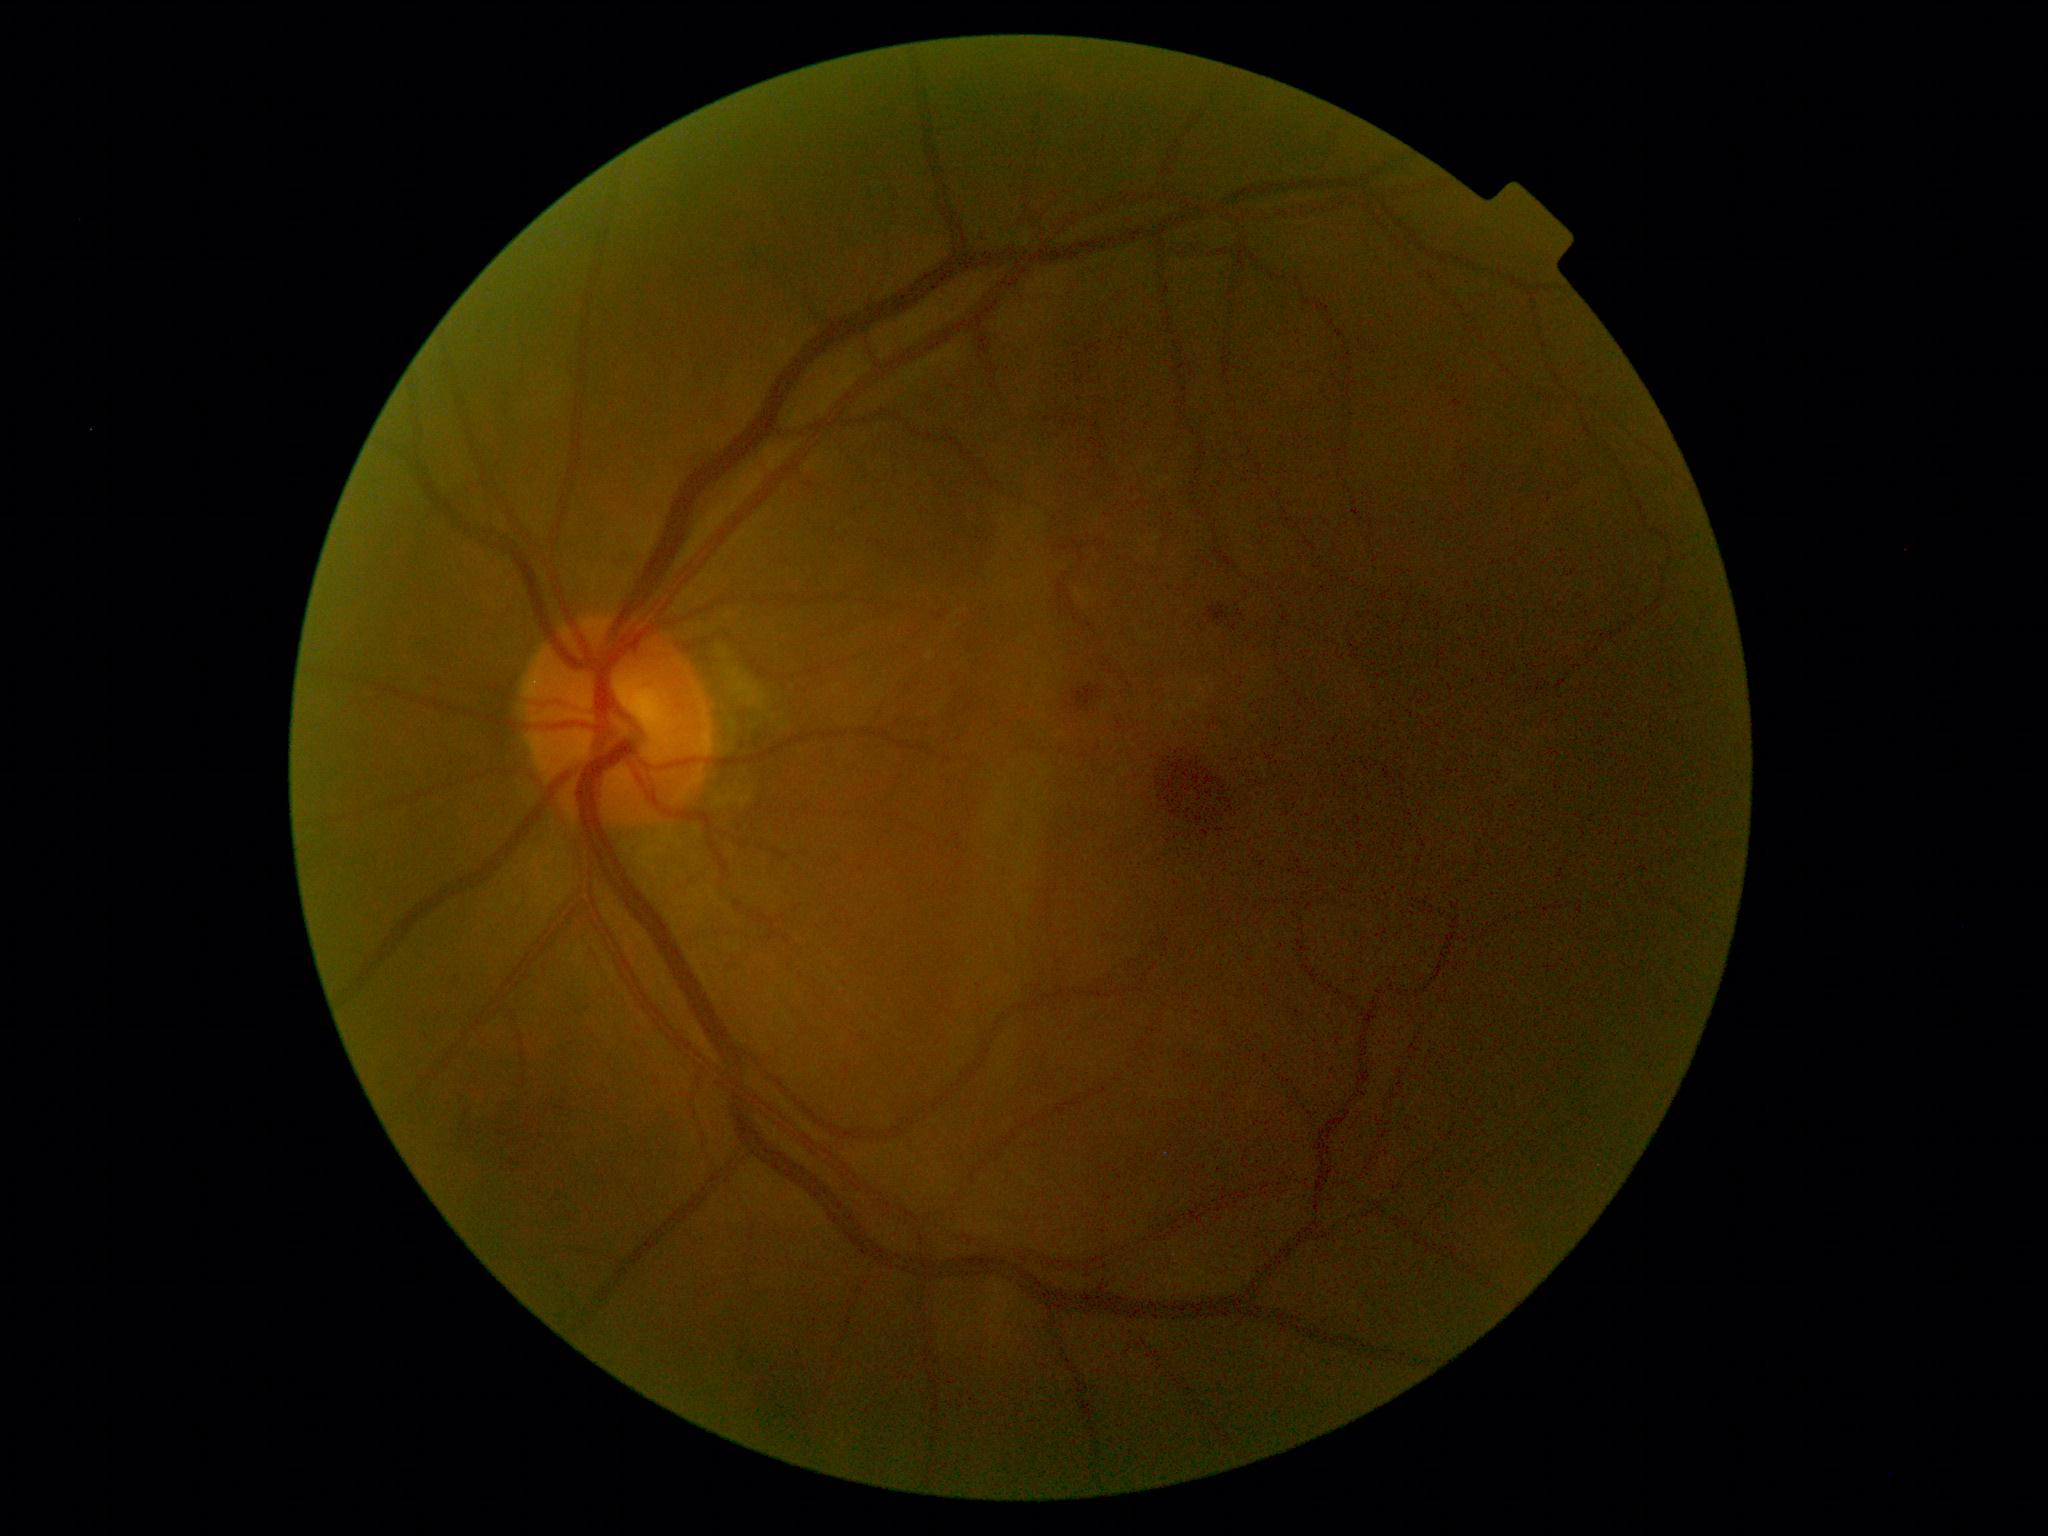

diabetic retinopathy (DR) = grade 2 (moderate NPDR).